45-degree field of view:
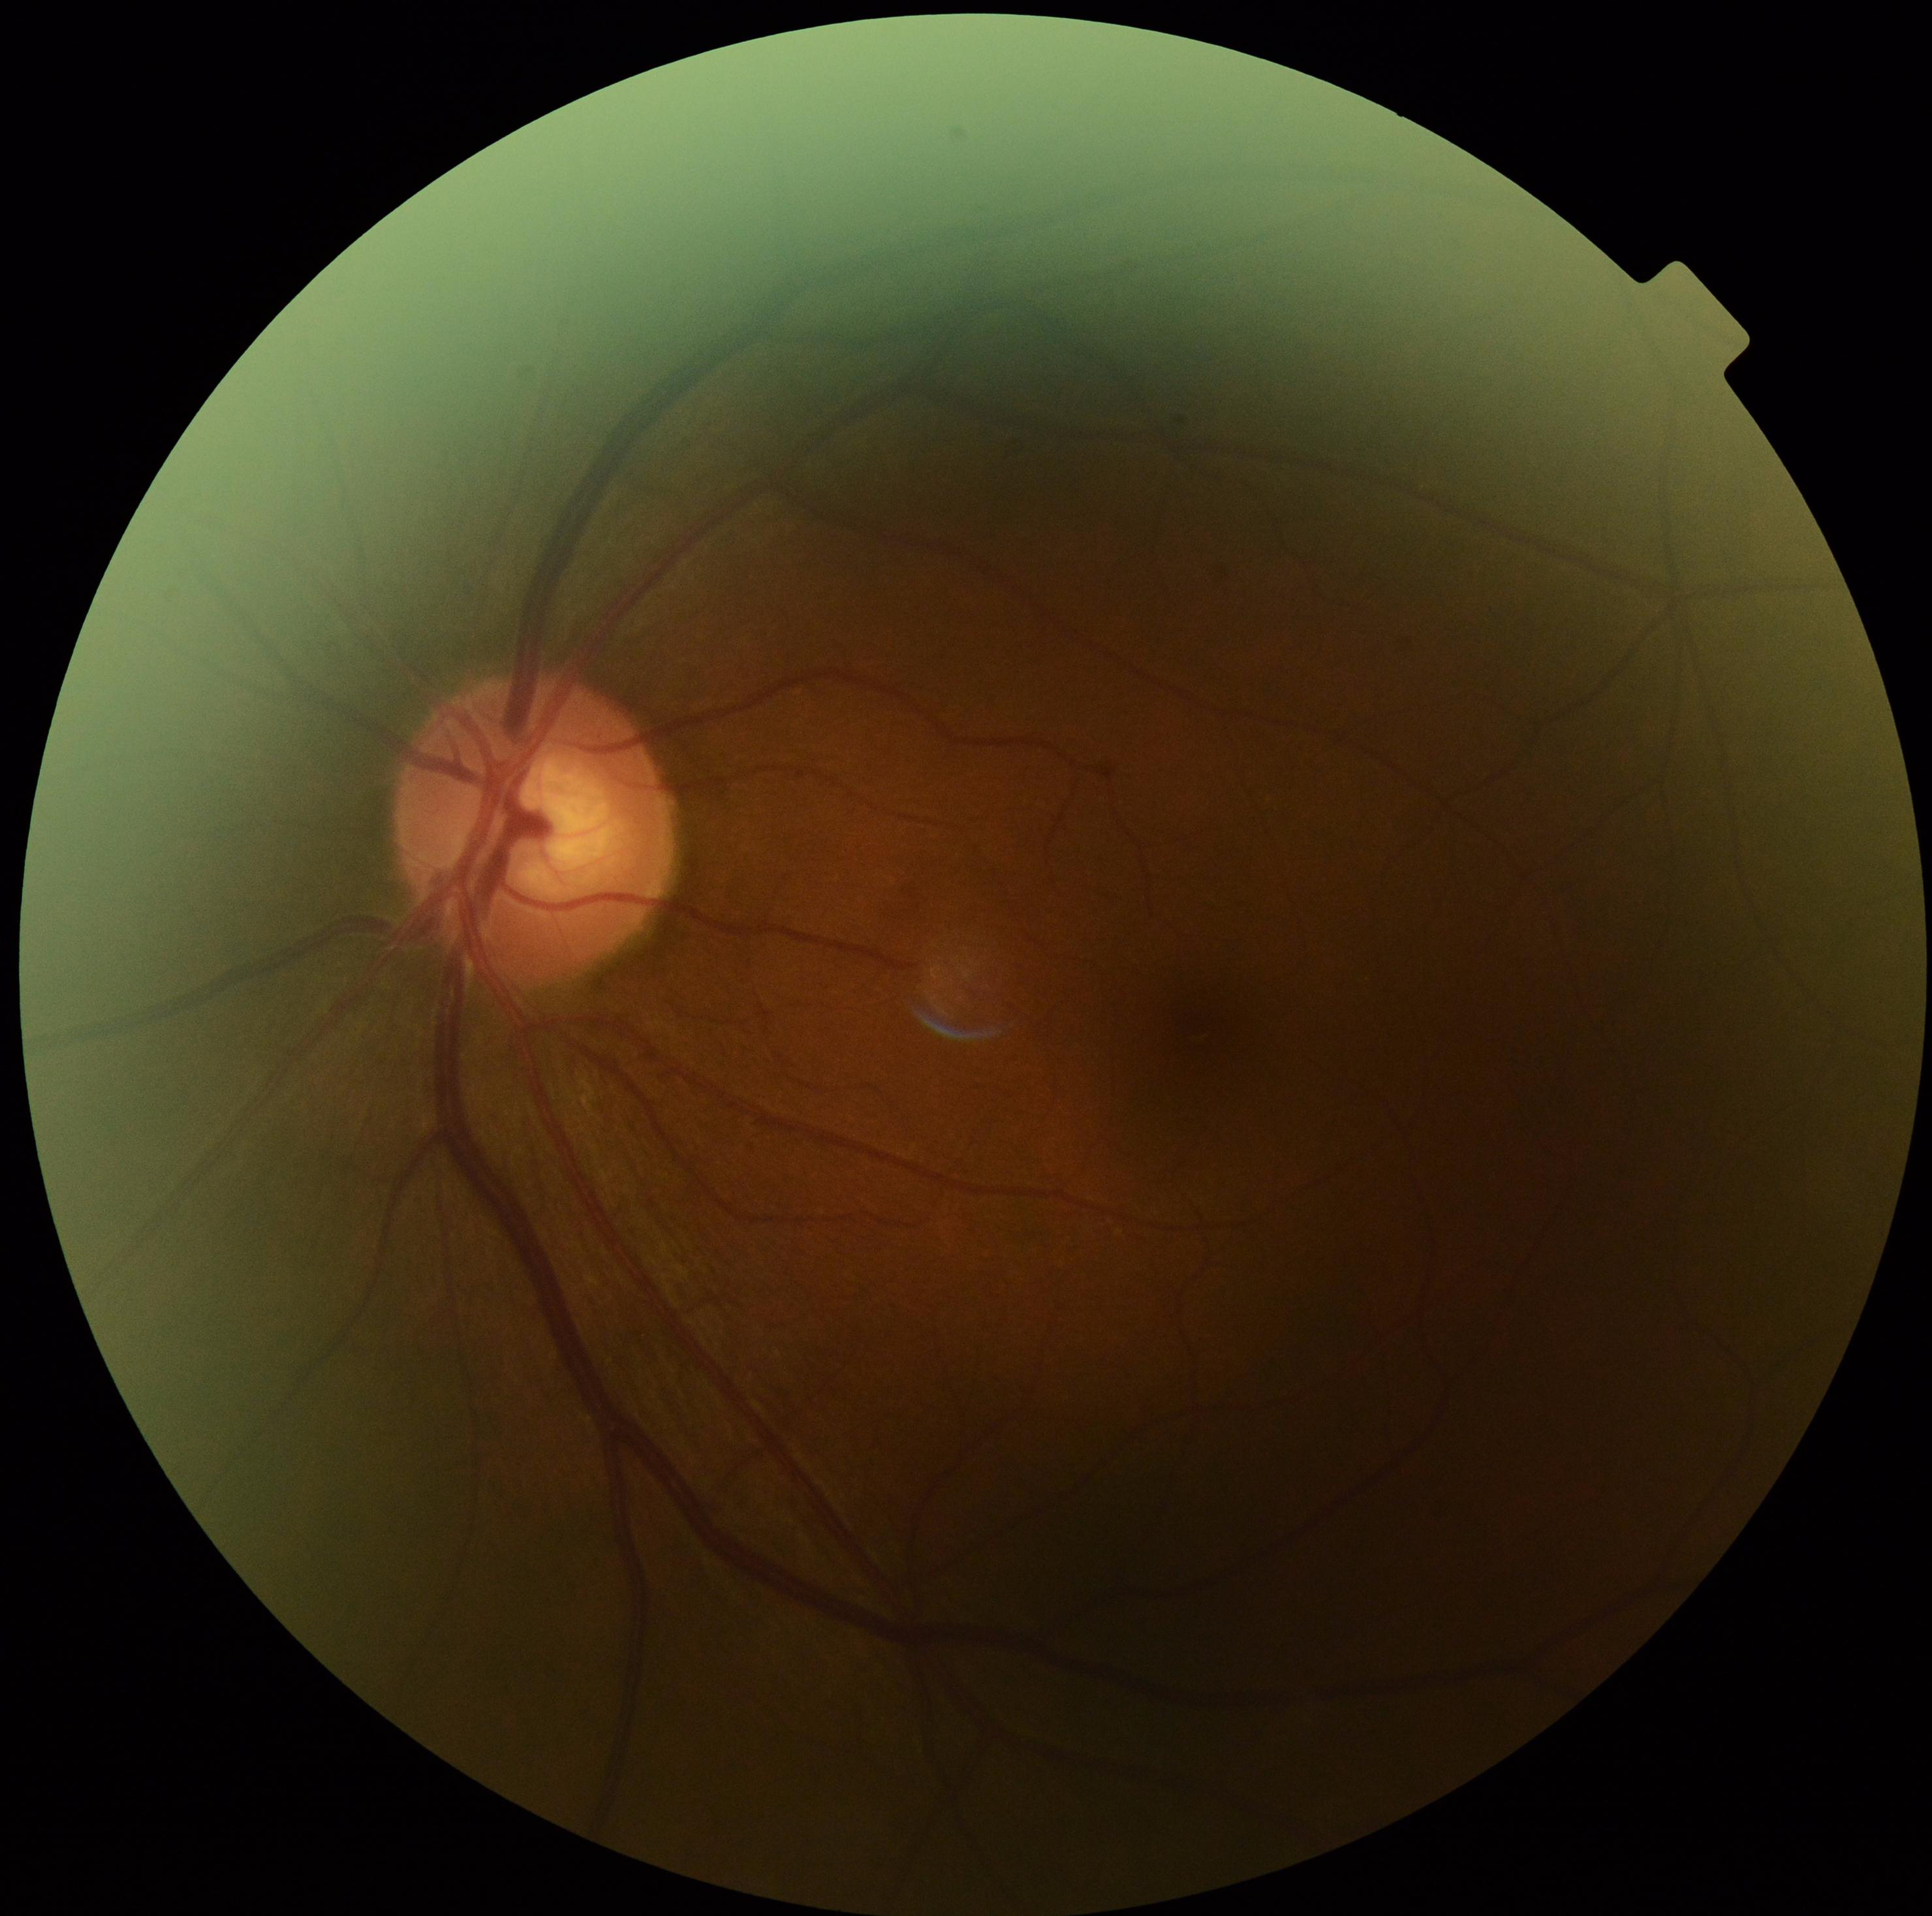
Diabetic retinopathy: grade 0 (no apparent retinopathy).